Clarity RetCam 3, 130° FOV · pediatric retinal photograph (wide-field) — 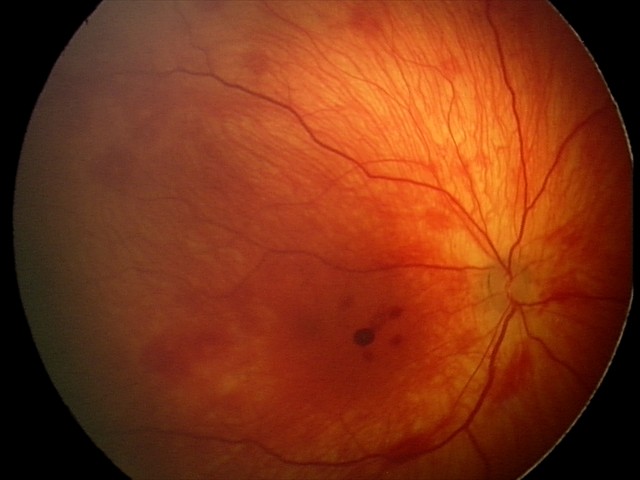

Impression: retinal hemorrhages.